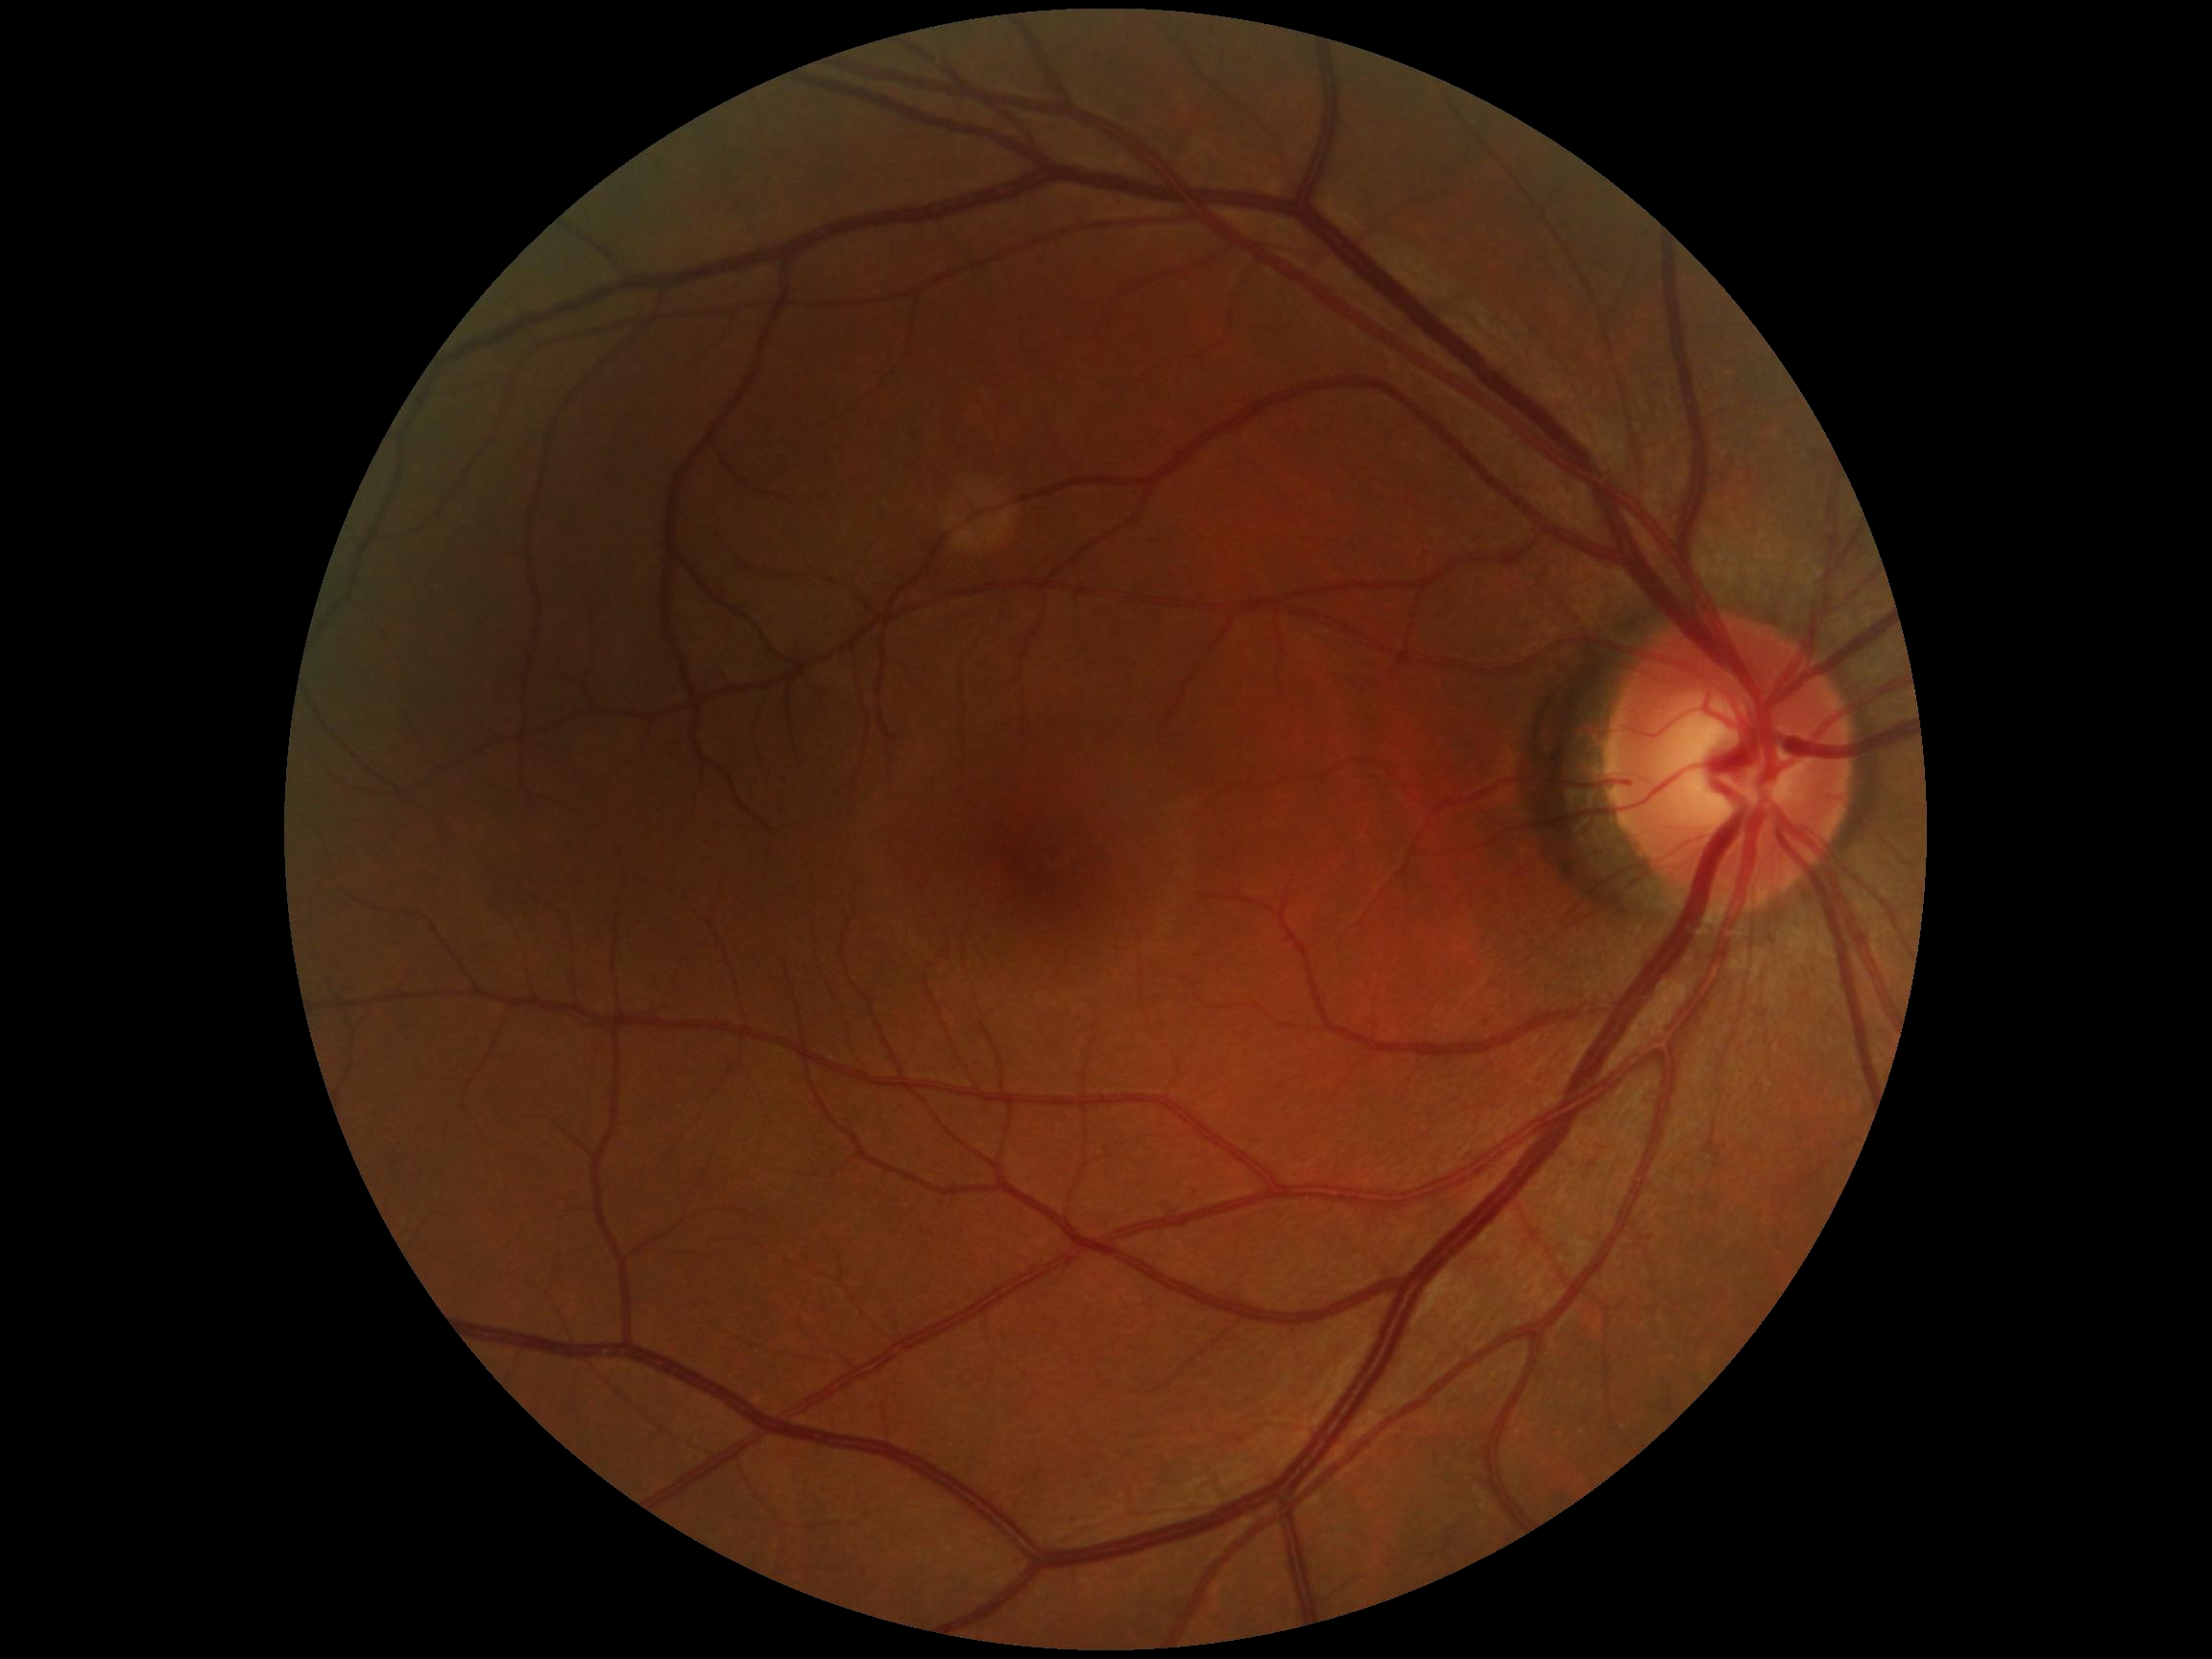

DR severity is no apparent retinopathy (grade 0) — no visible signs of diabetic retinopathy.